Wide-field fundus photograph of an infant; 130° field of view (Clarity RetCam 3): 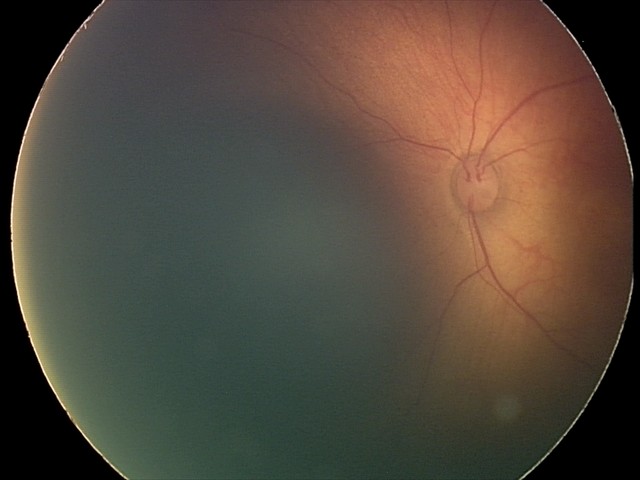

Screening series with retinal hemorrhages.